Wide-field fundus photograph of an infant.
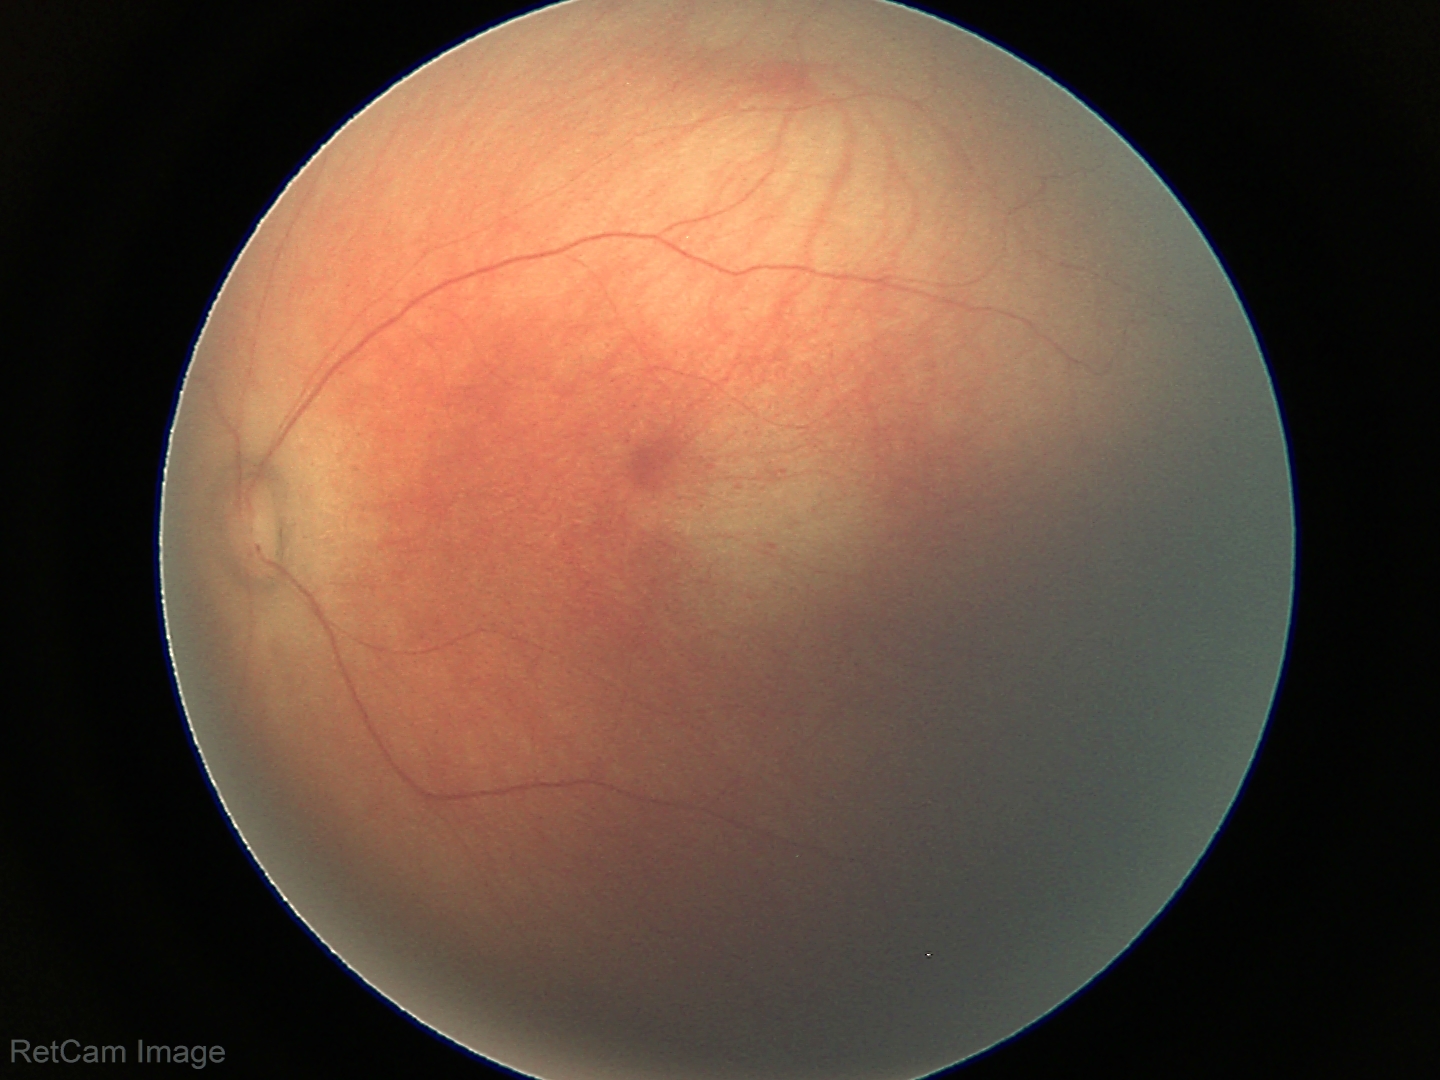 Physiological retinal appearance for postconceptual age.